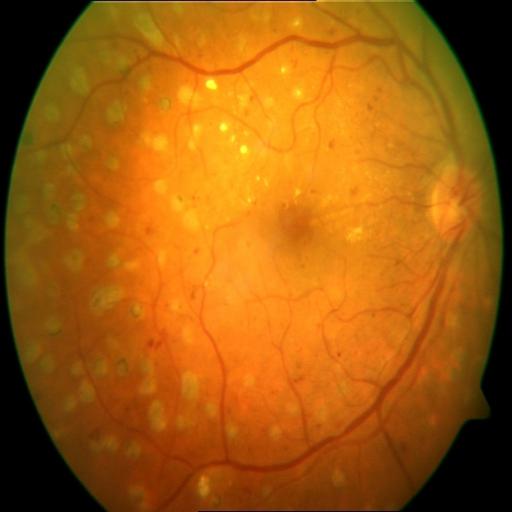
Findings consistent with microaneurysms and laser scars.